Image size 2048x1536. Retinal fundus photograph:
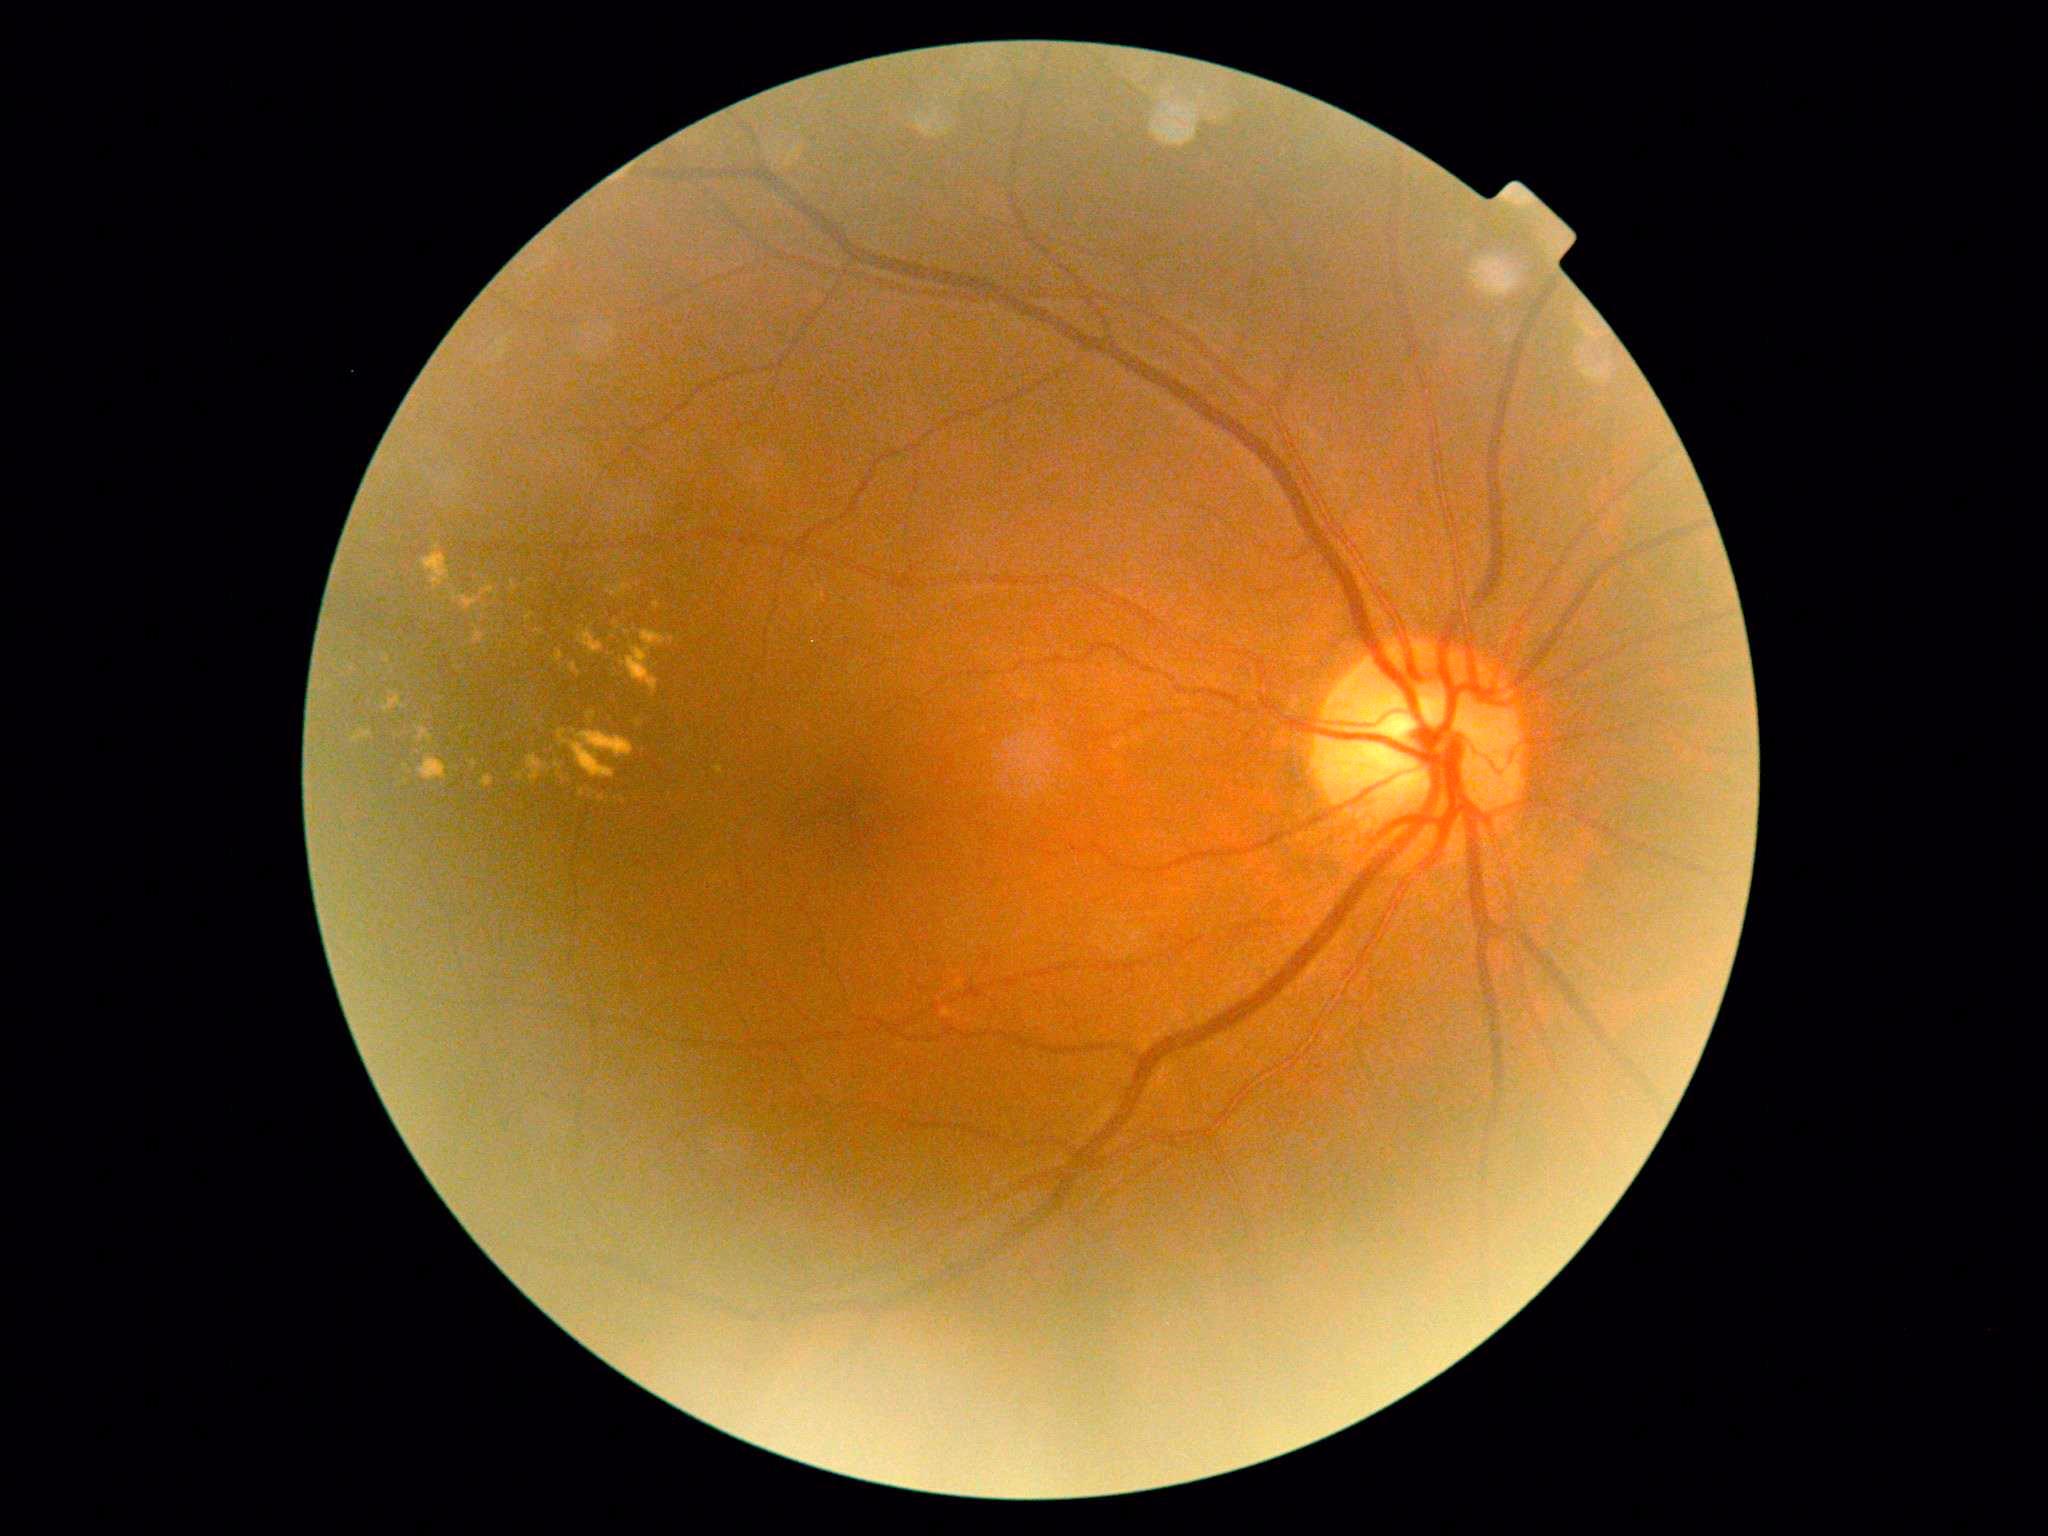 DR is moderate NPDR (grade 2).